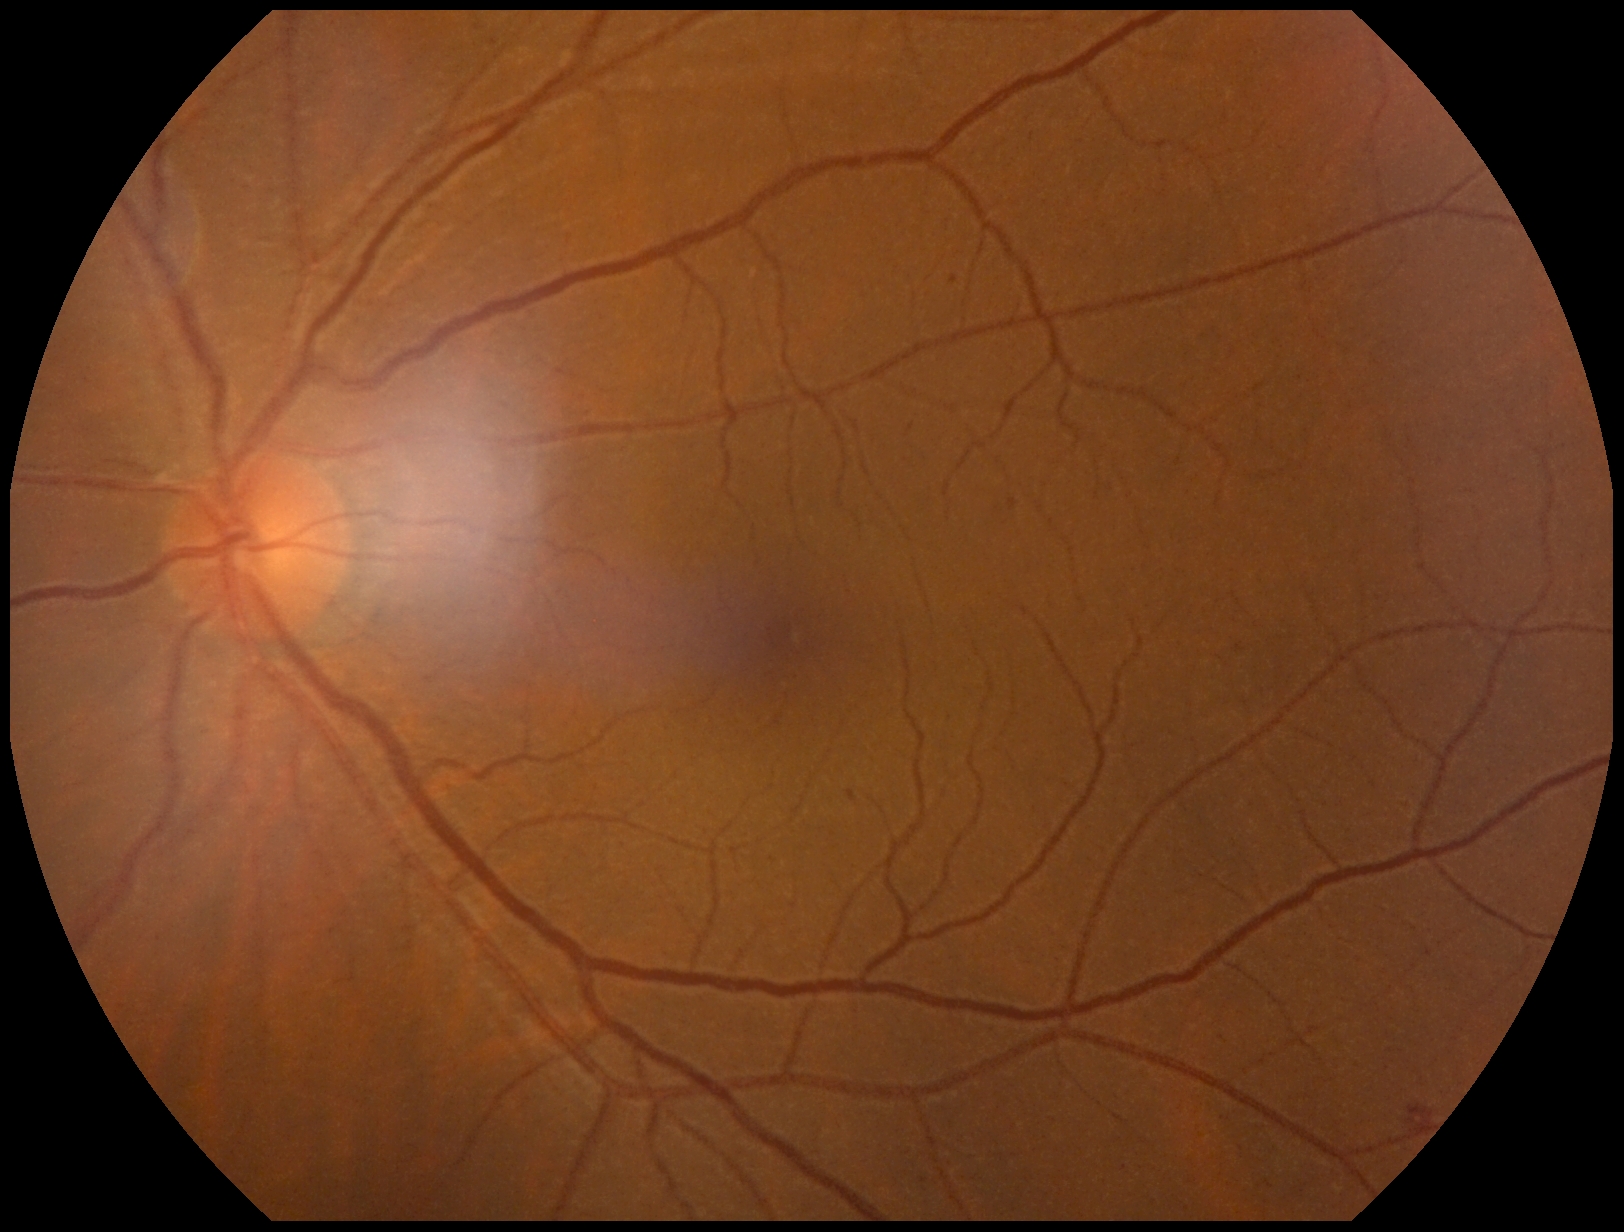 DR grade=moderate NPDR (2), DR class=non-proliferative diabetic retinopathy.